45° FOV, NIDEK AFC-230 fundus camera — 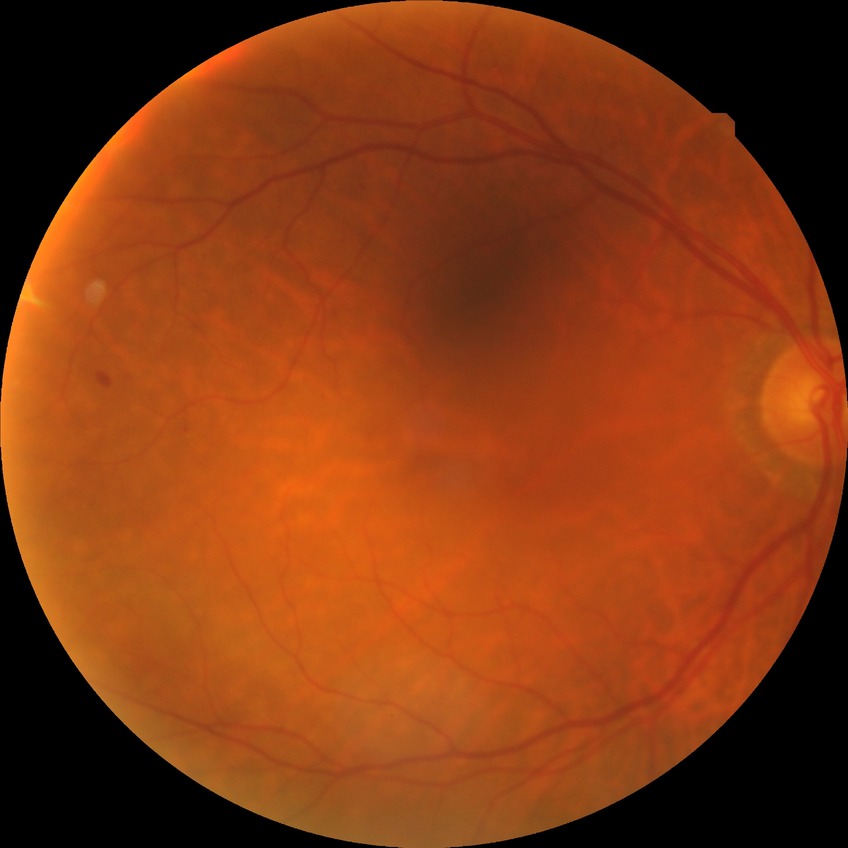

davis_grade: NDR (no diabetic retinopathy)